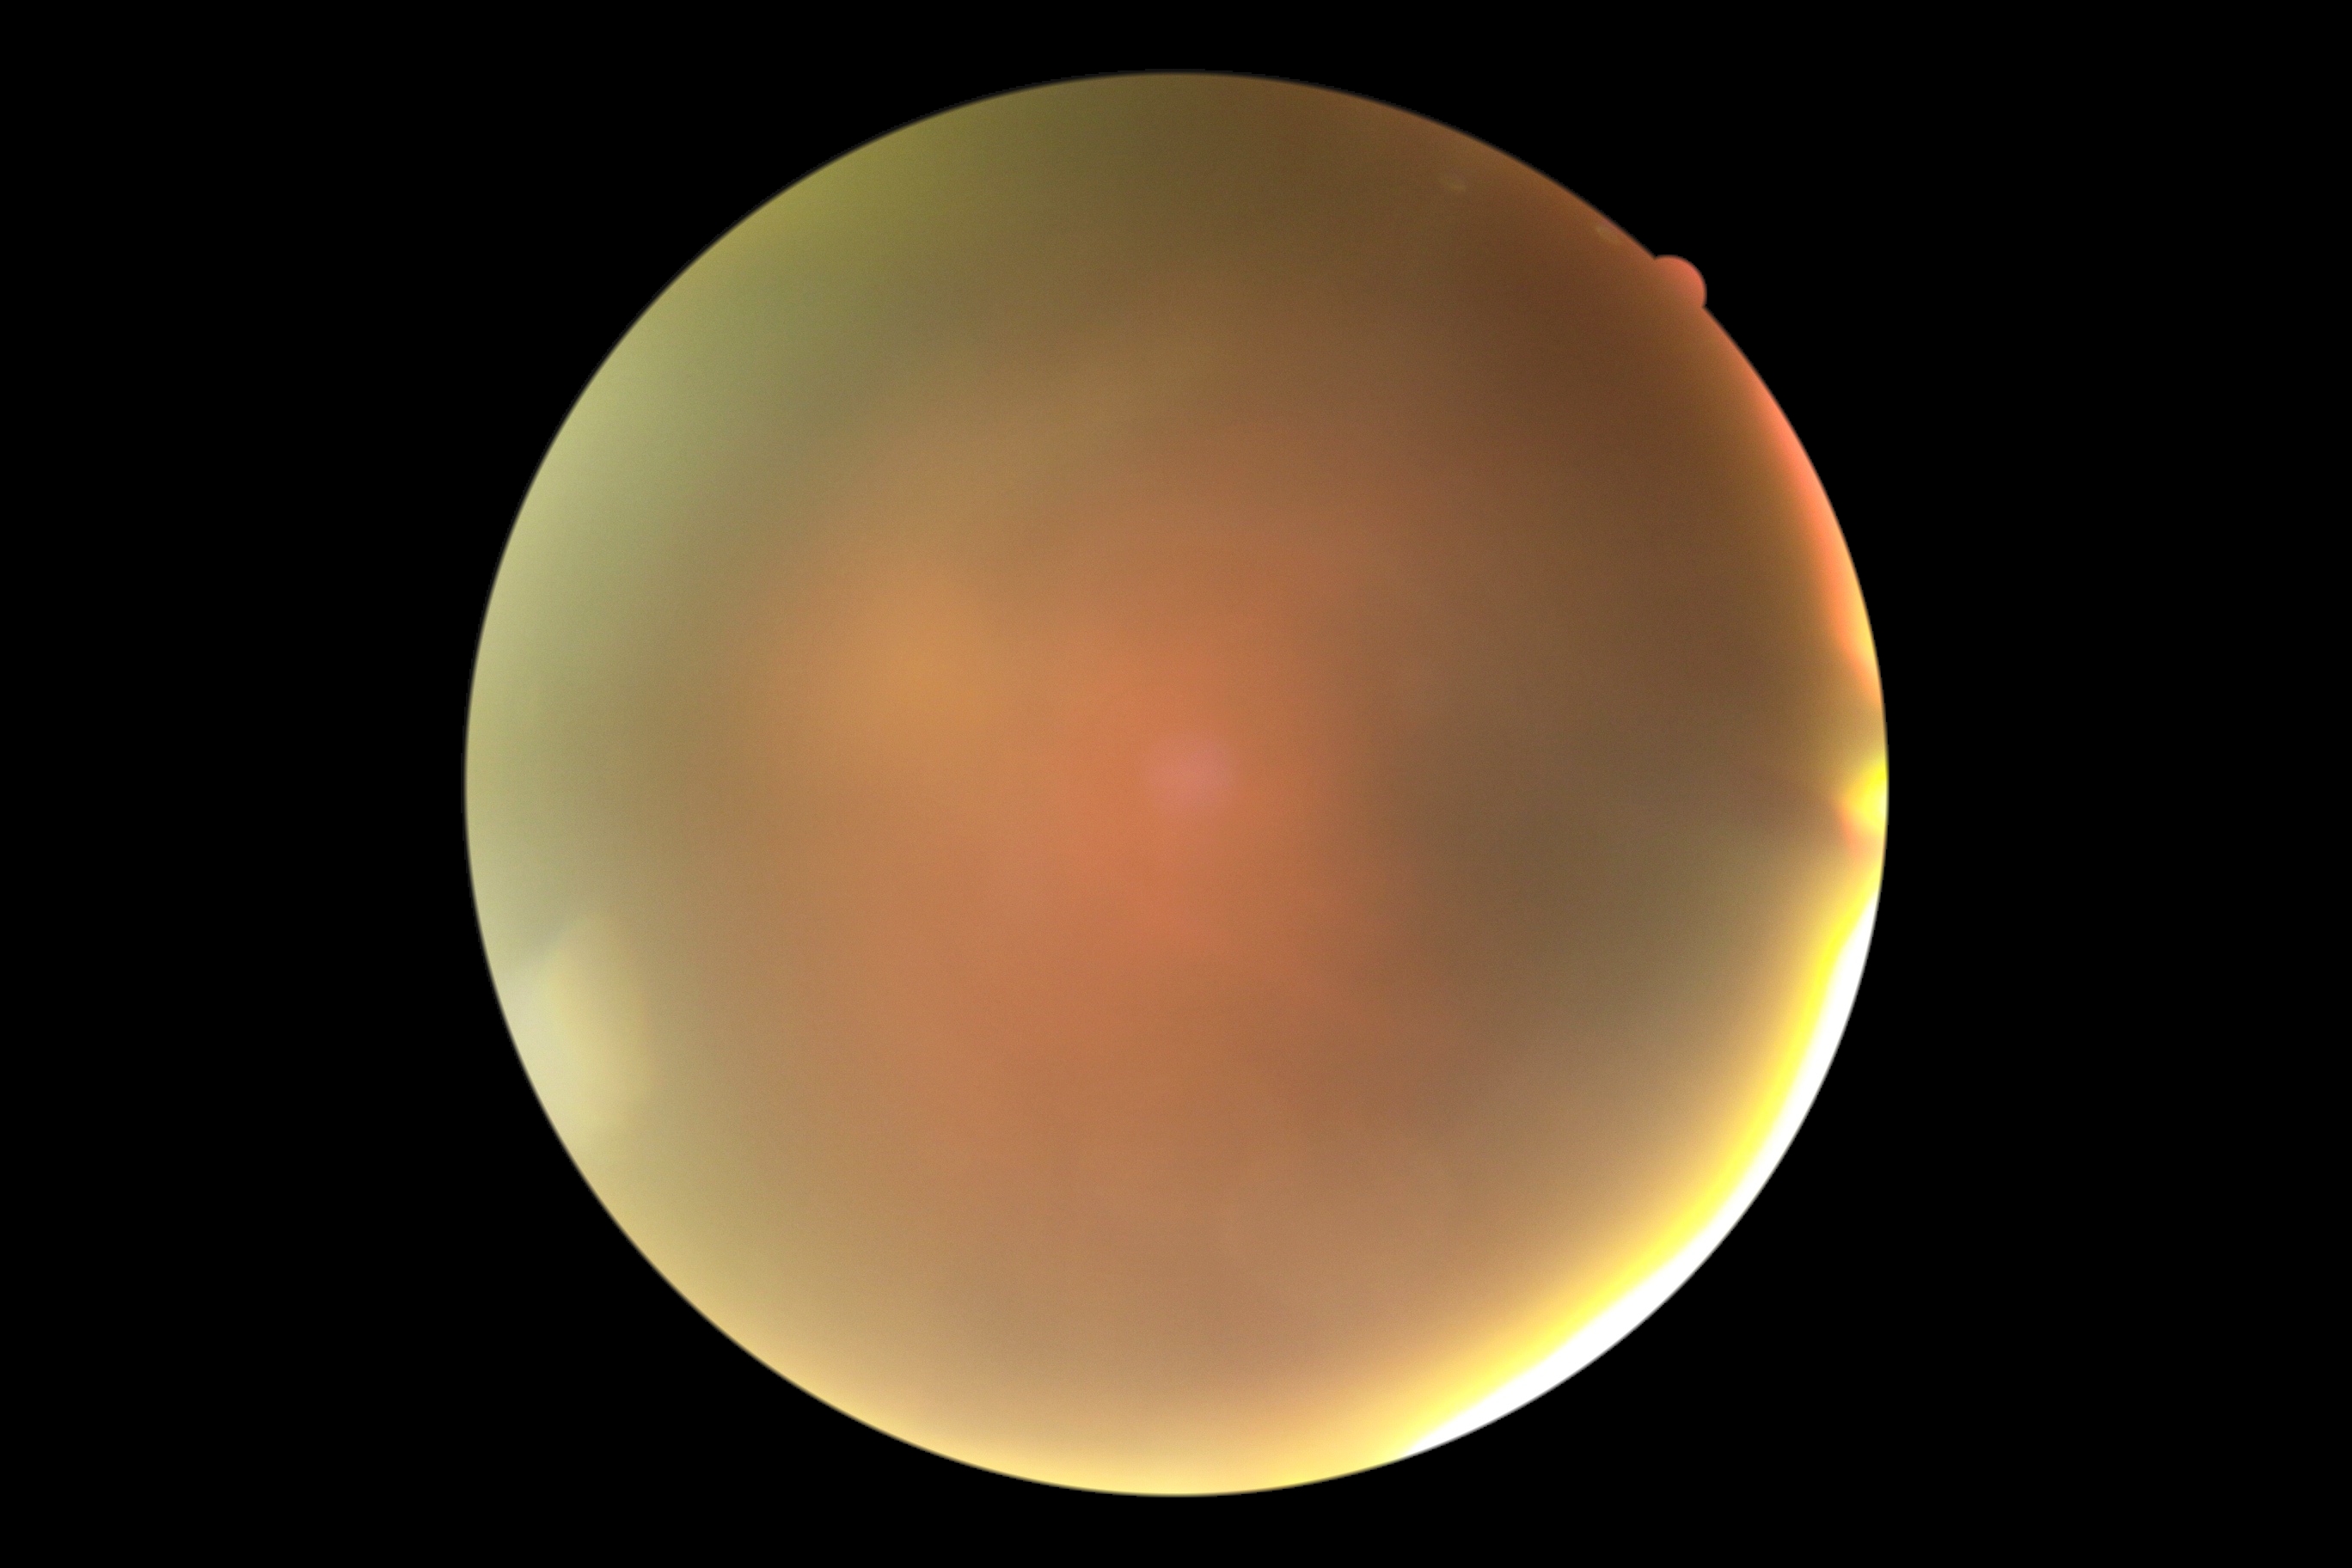
DR is ungradable due to poor image quality.